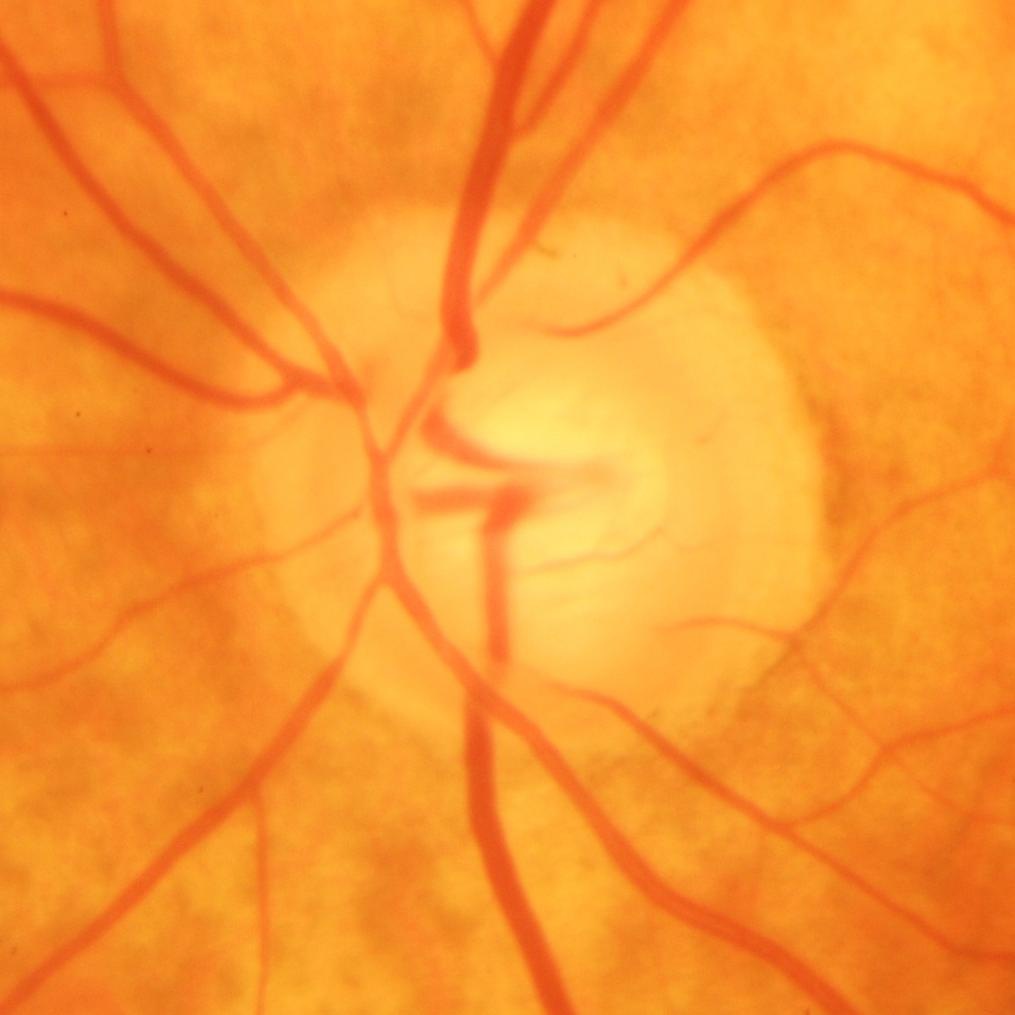 Glaucomatous changes are present. Glaucoma status = glaucomatous damage to the optic nerve.